Fundus photo; 2352 by 1568 pixels; 45-degree field of view — 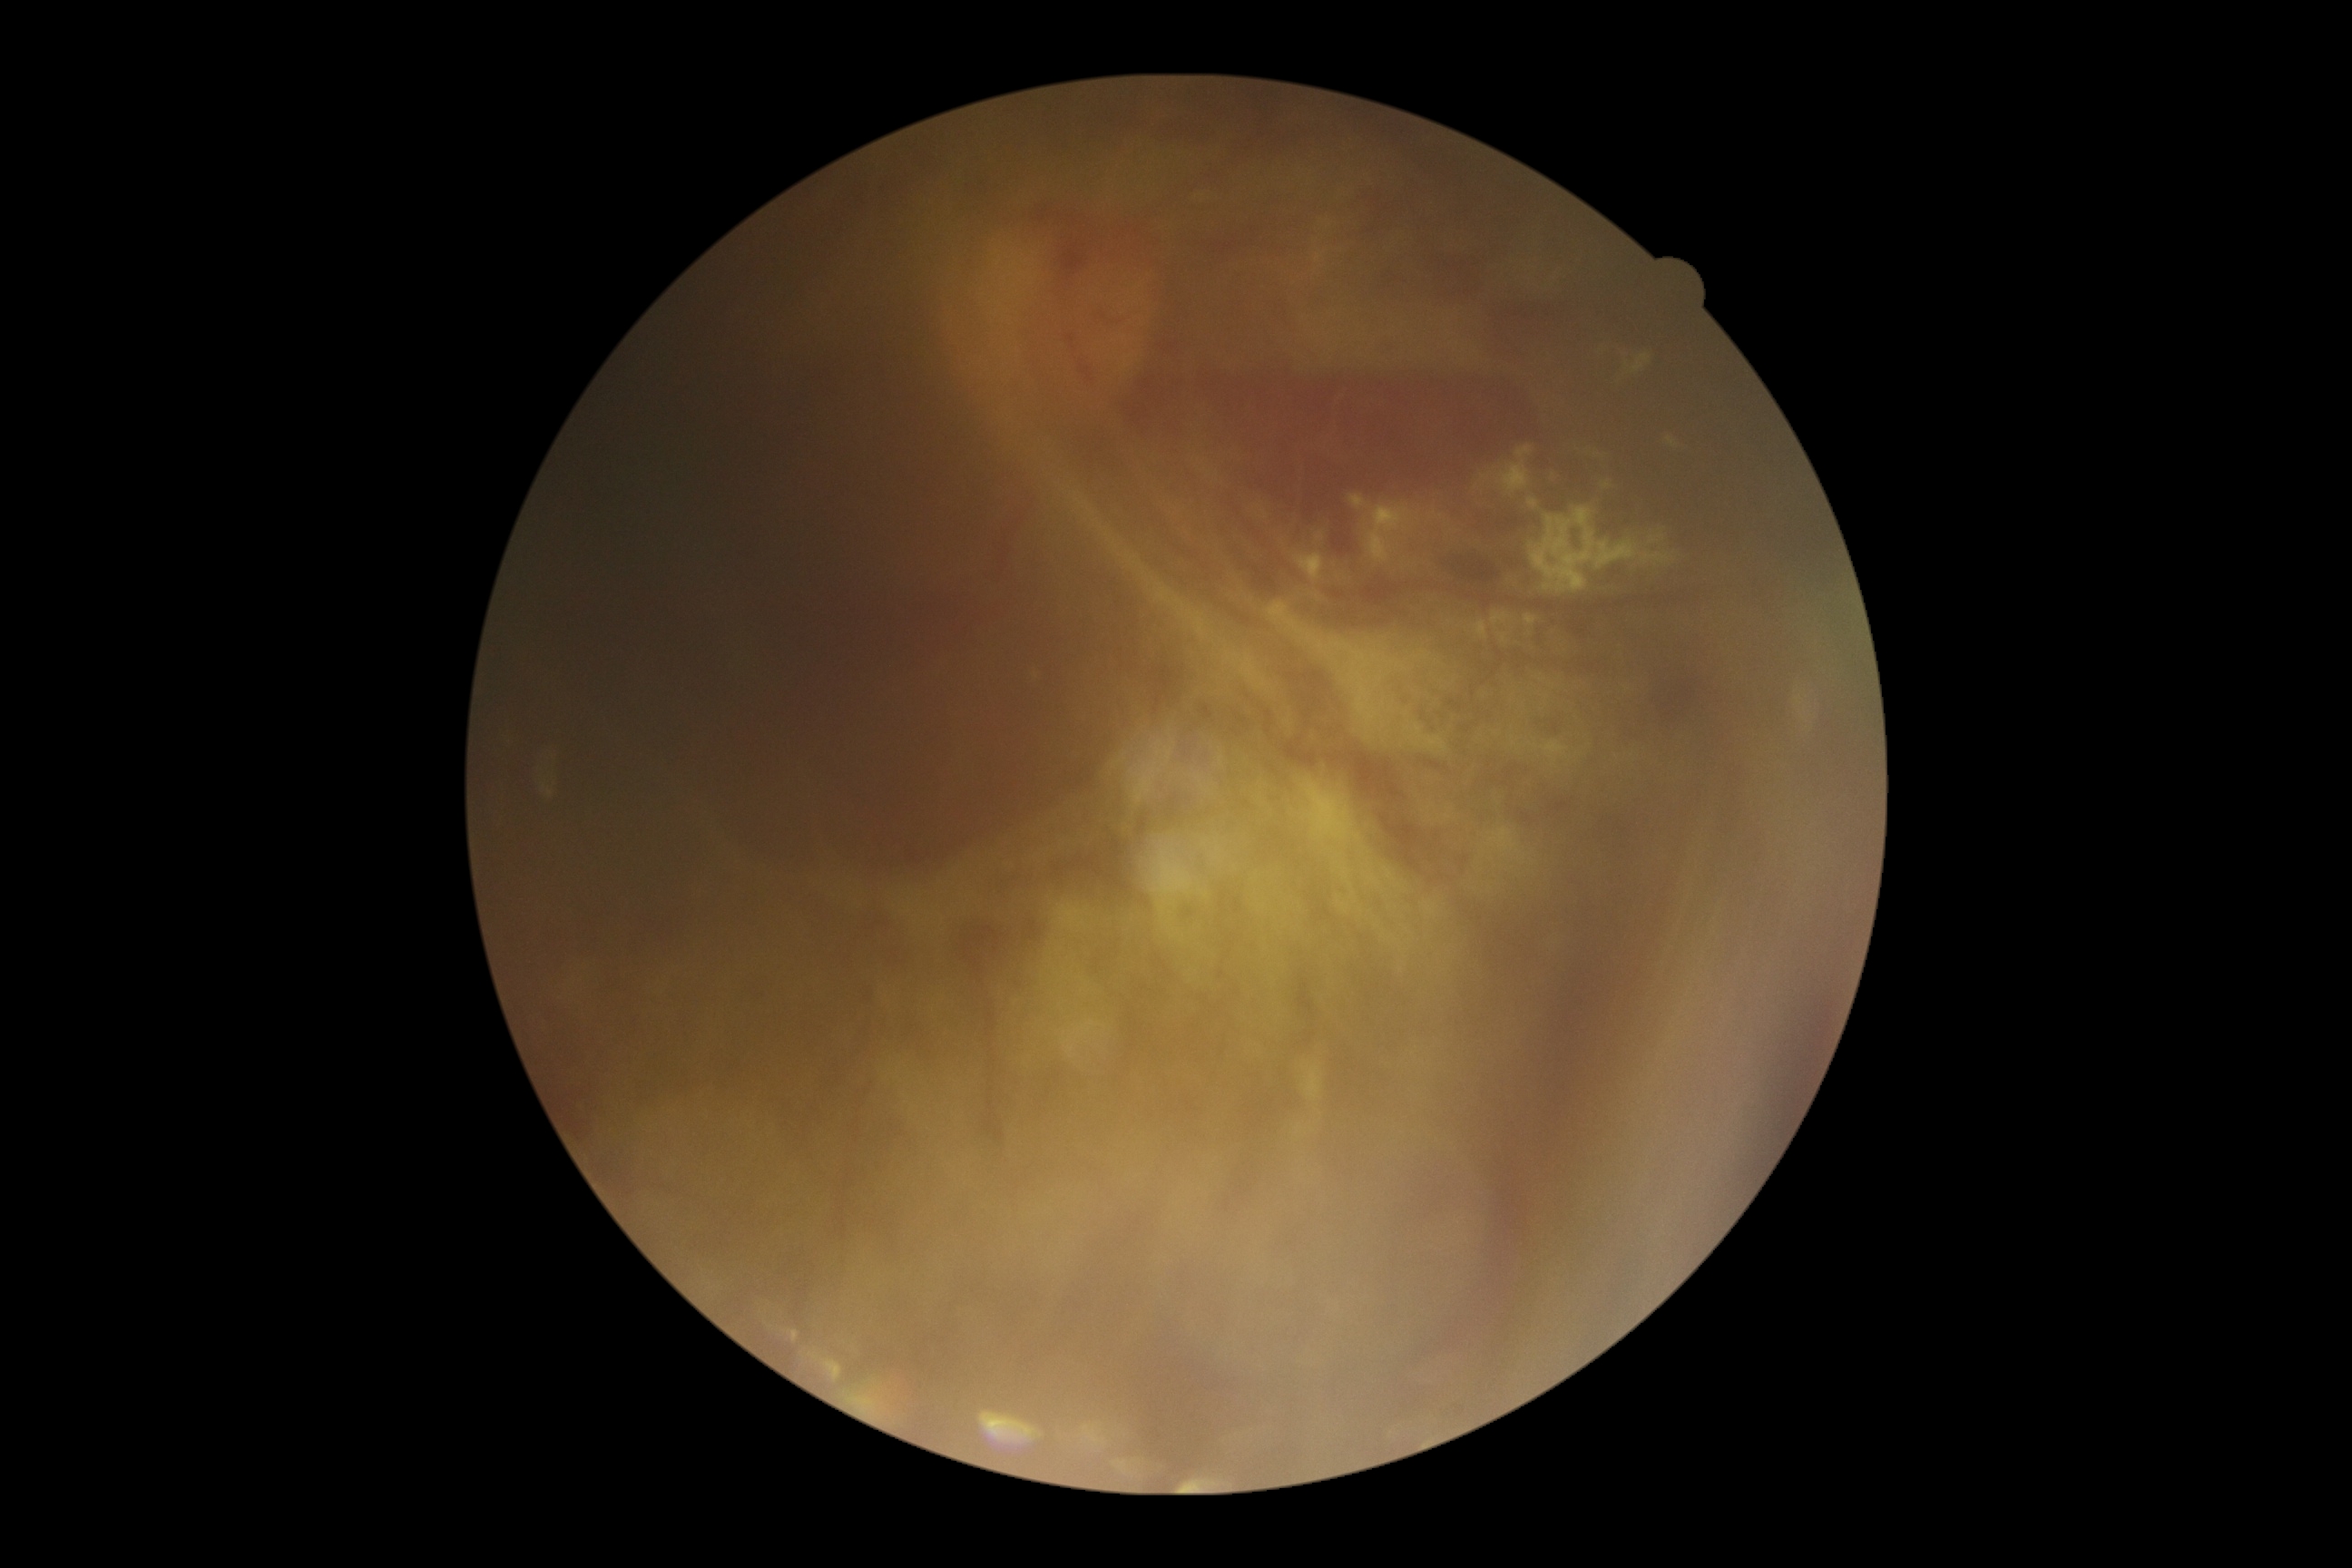 dr_grade: grade 4 (PDR) — neovascularization and/or vitreous/pre-retinal hemorrhage